Retinal fundus photograph
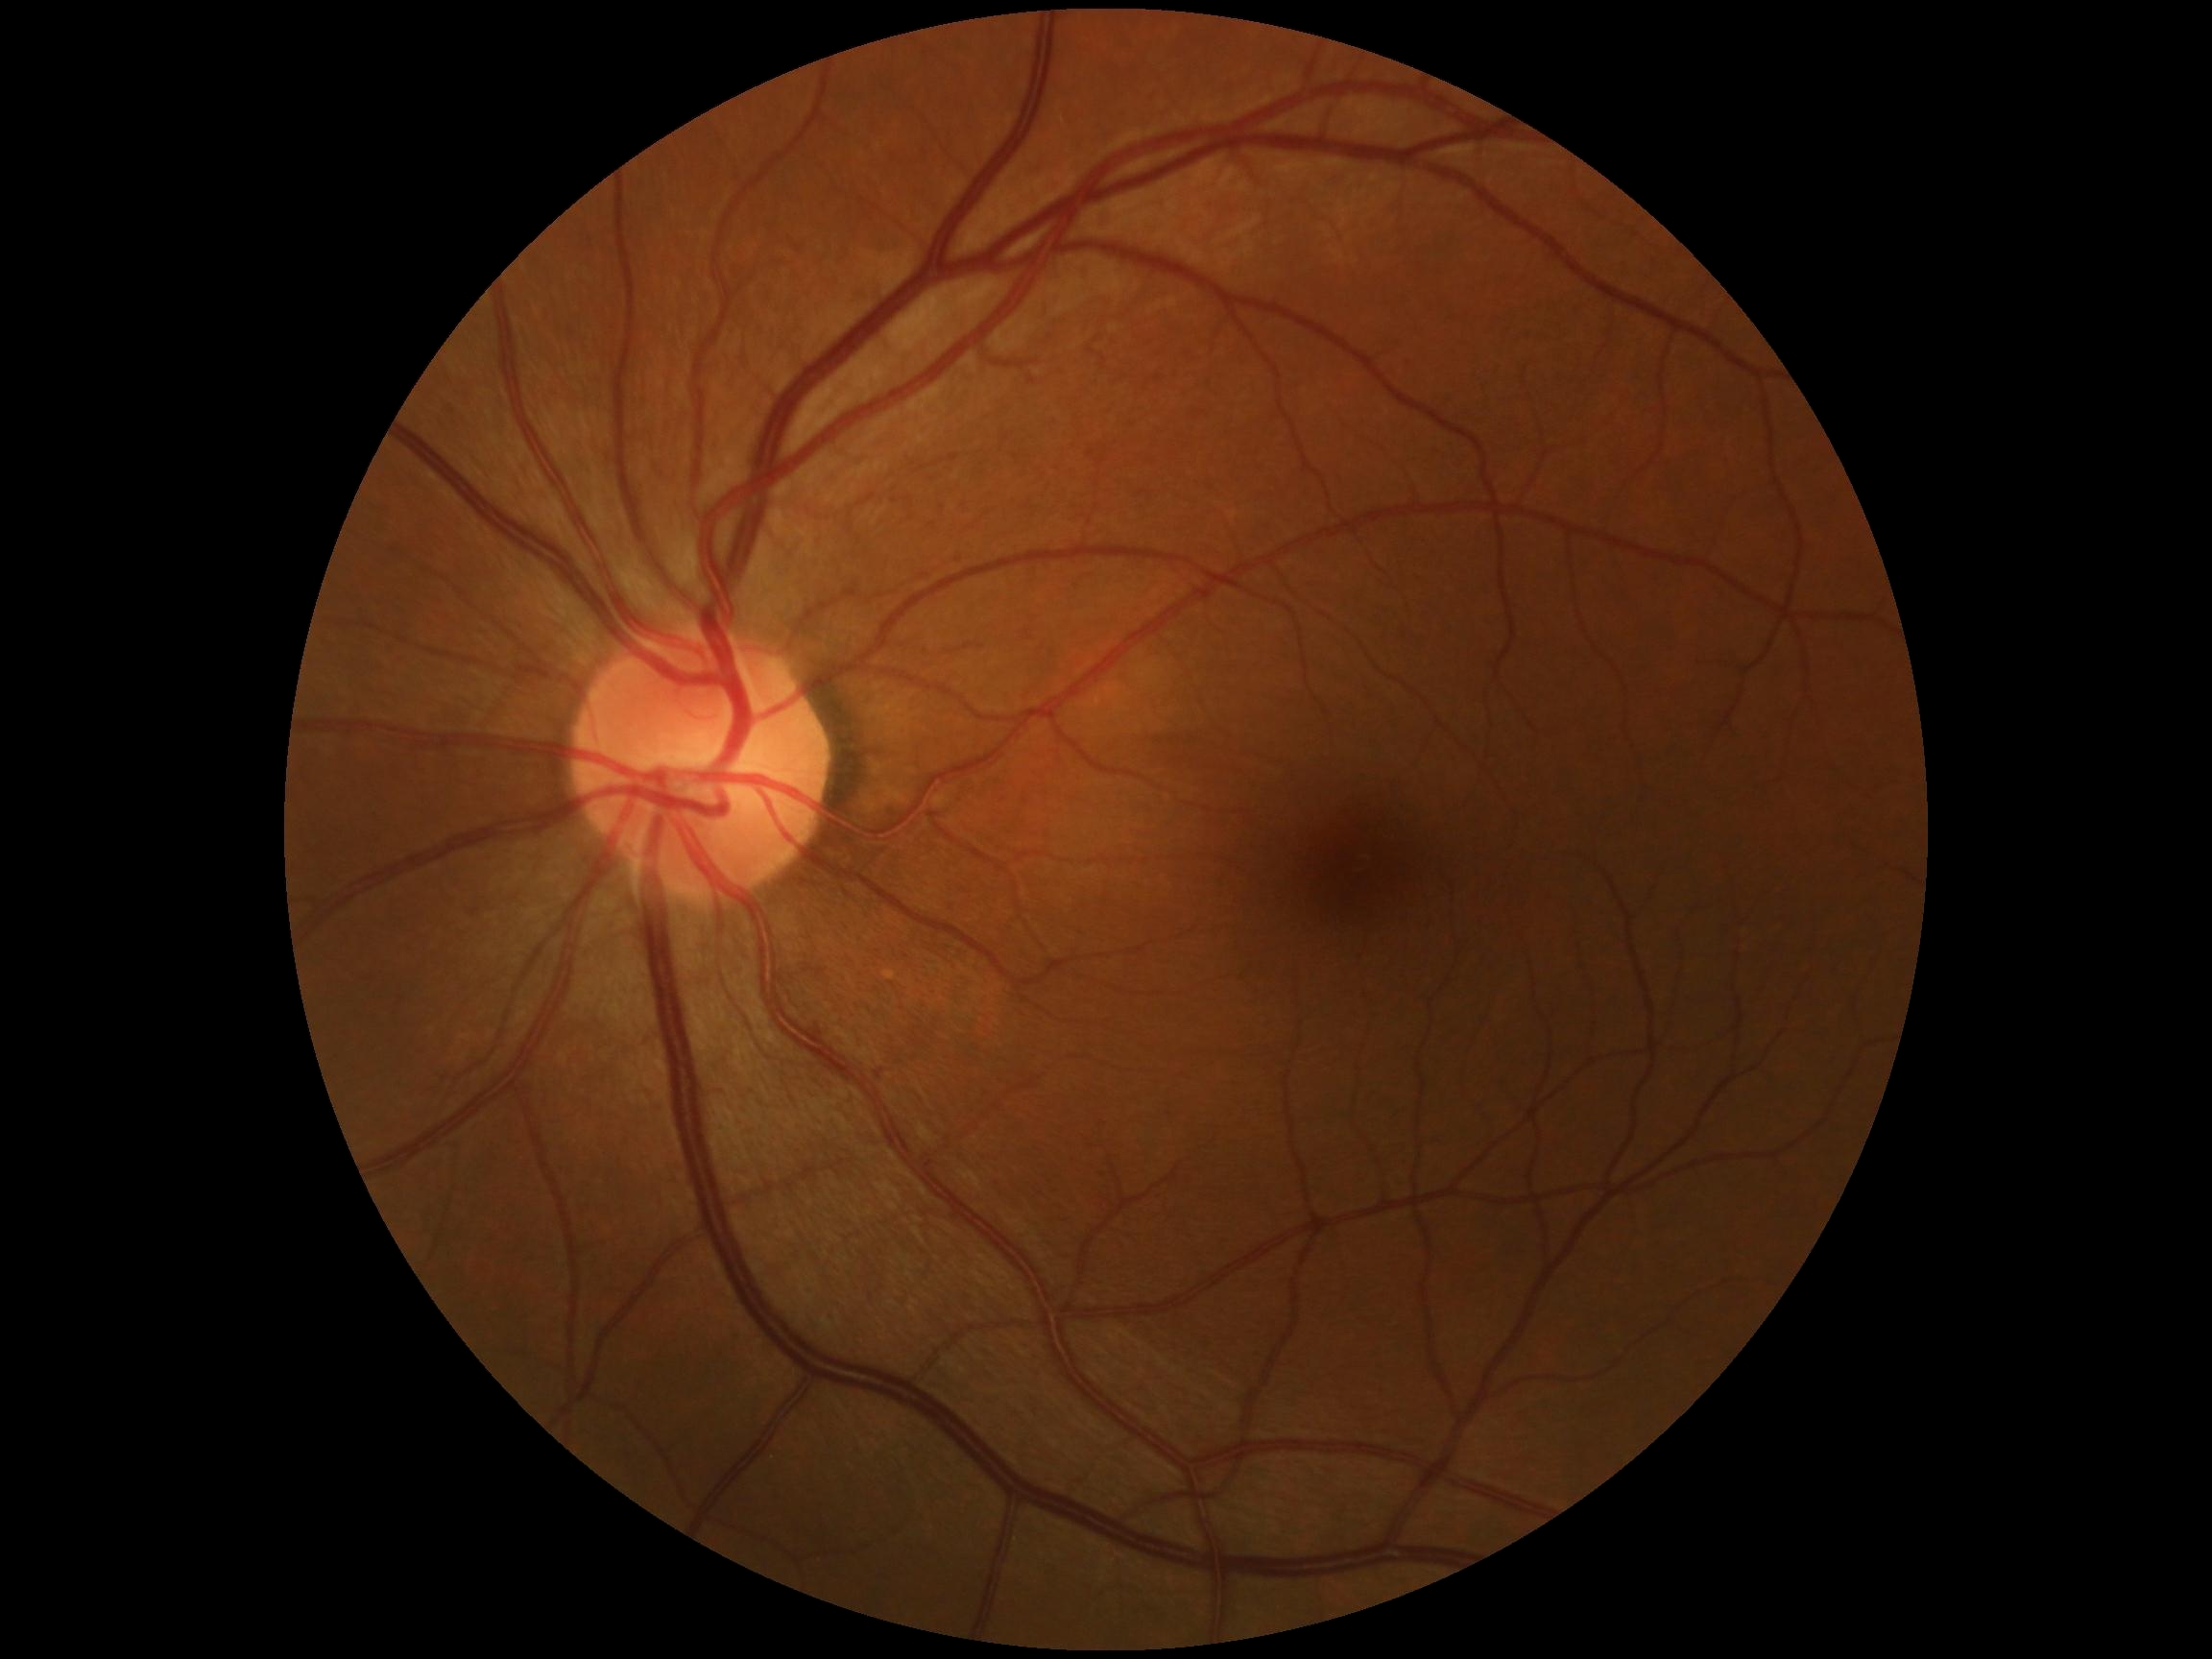 DR severity is no apparent diabetic retinopathy (grade 0) — no visible signs of diabetic retinopathy.